Image size 2346x1568; FOV: 45 degrees; CFP — 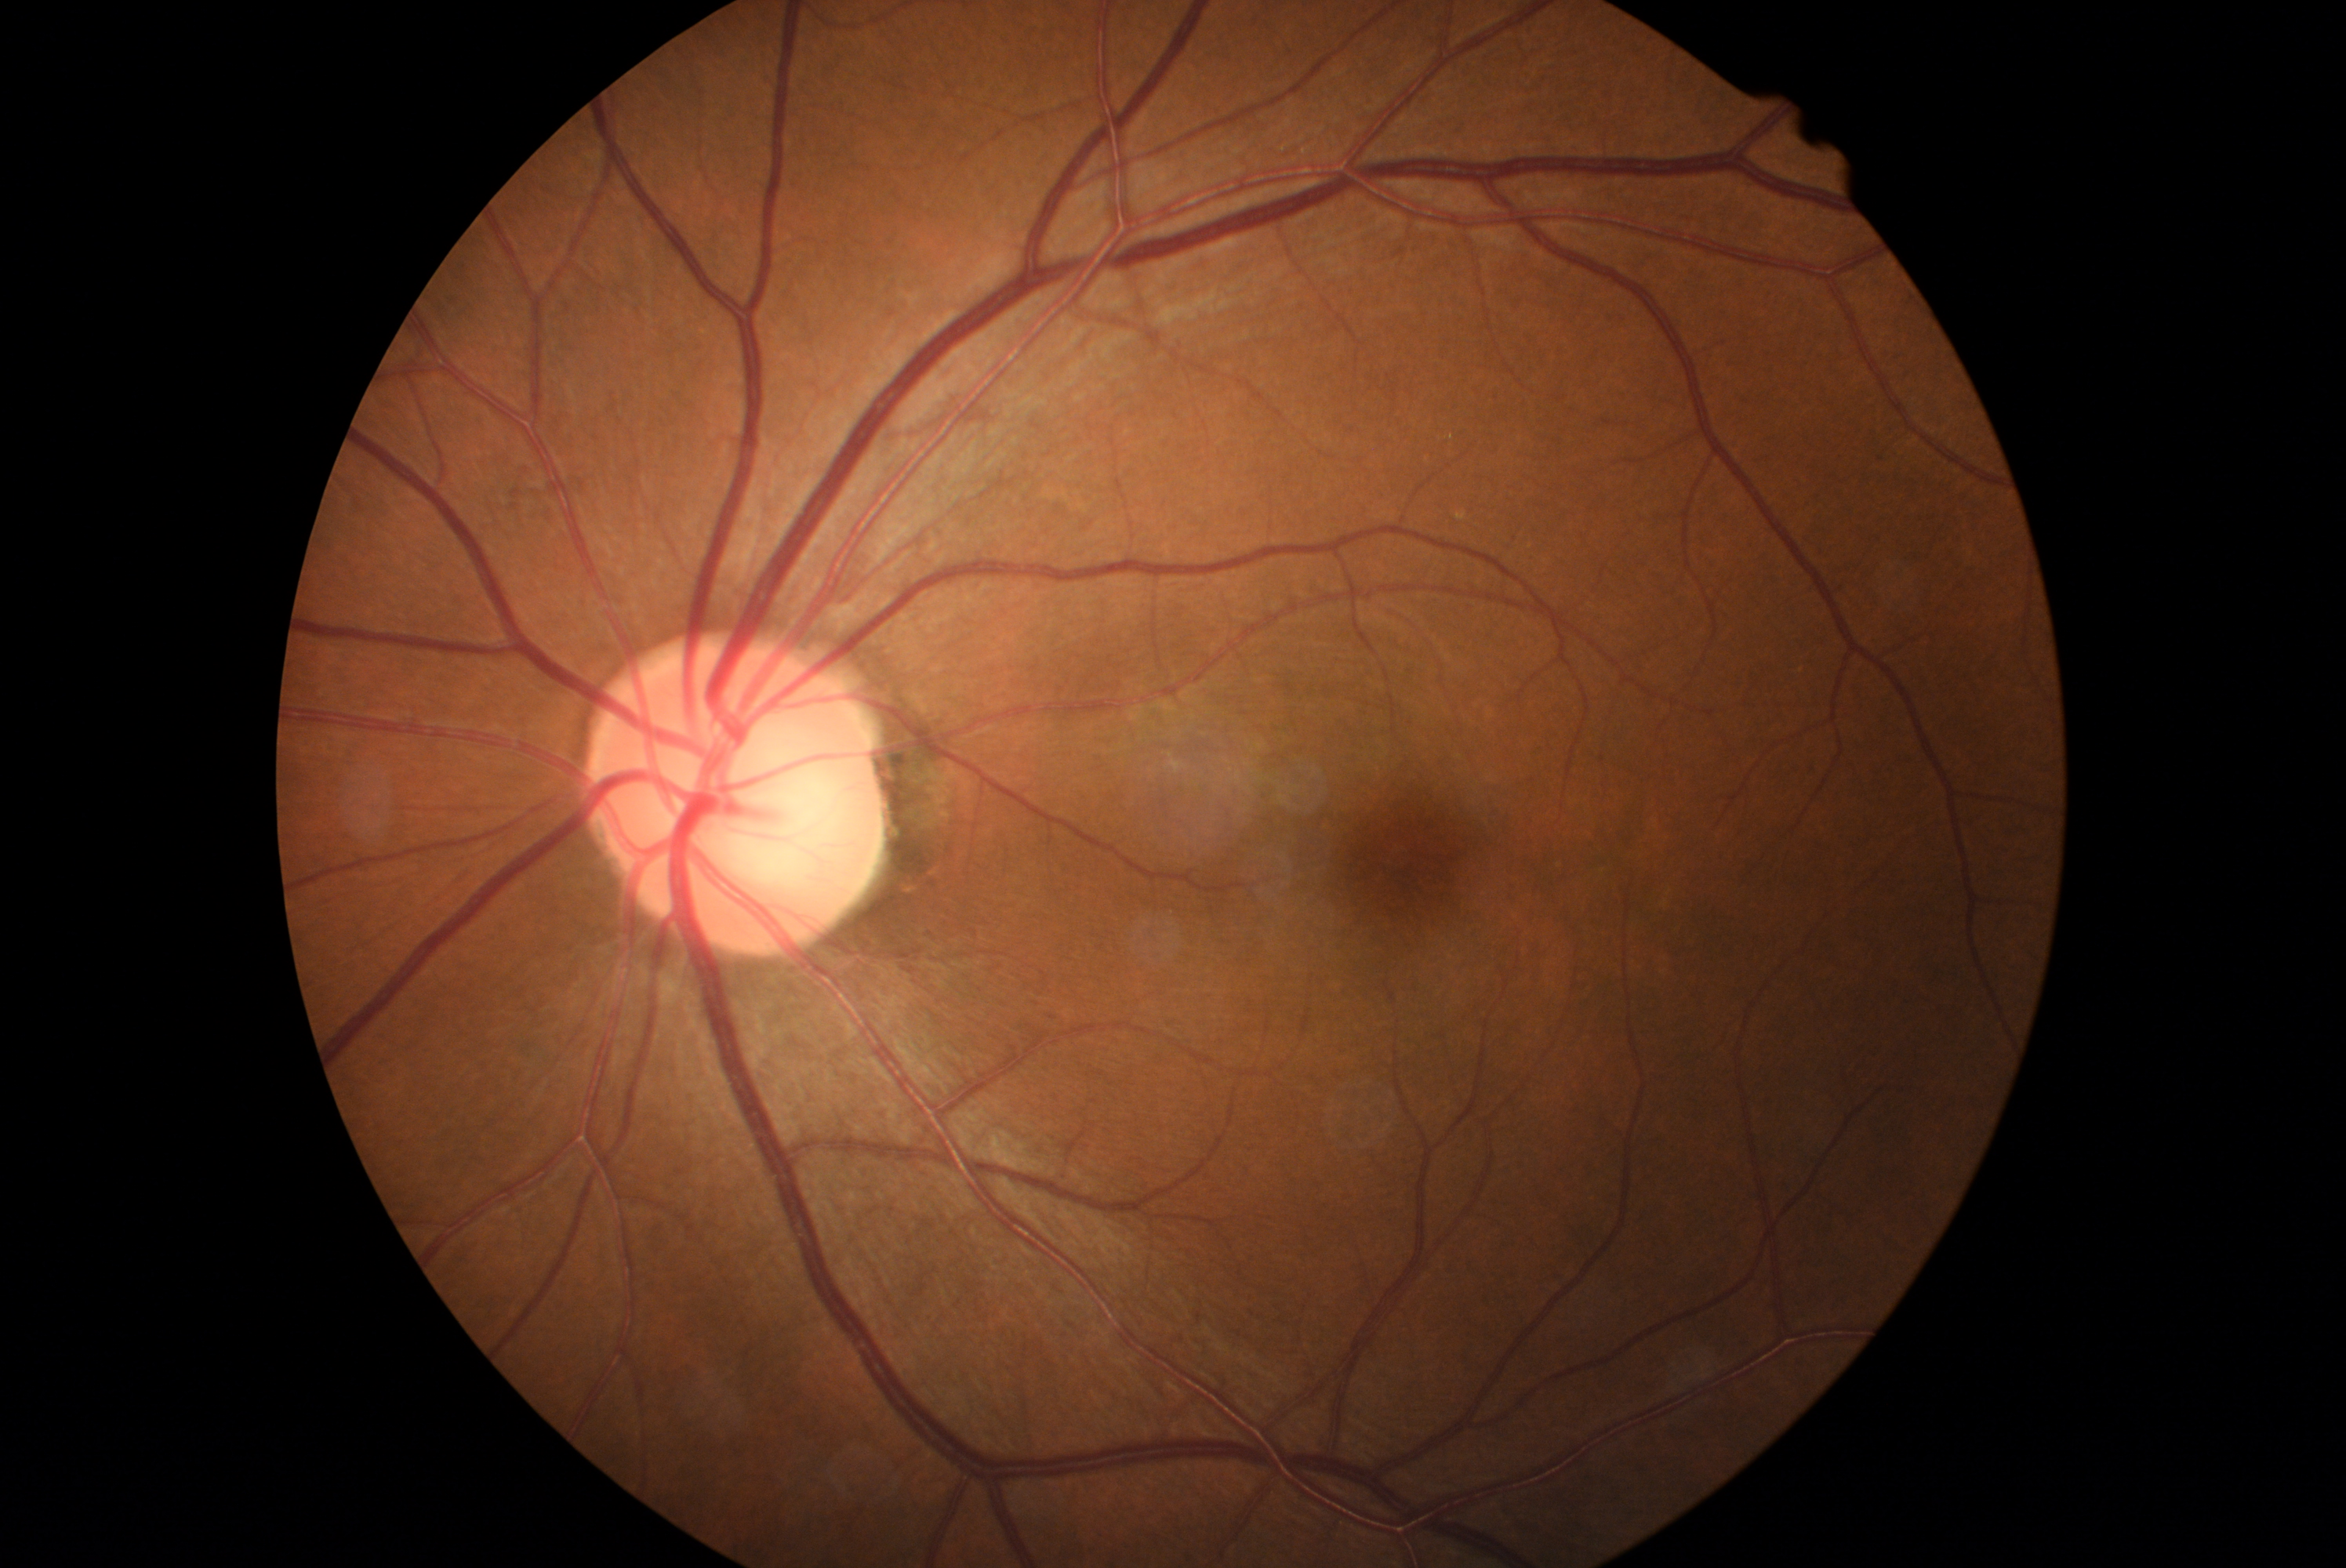

Diabetic retinopathy is 0.